2352x1568px; 45° FOV
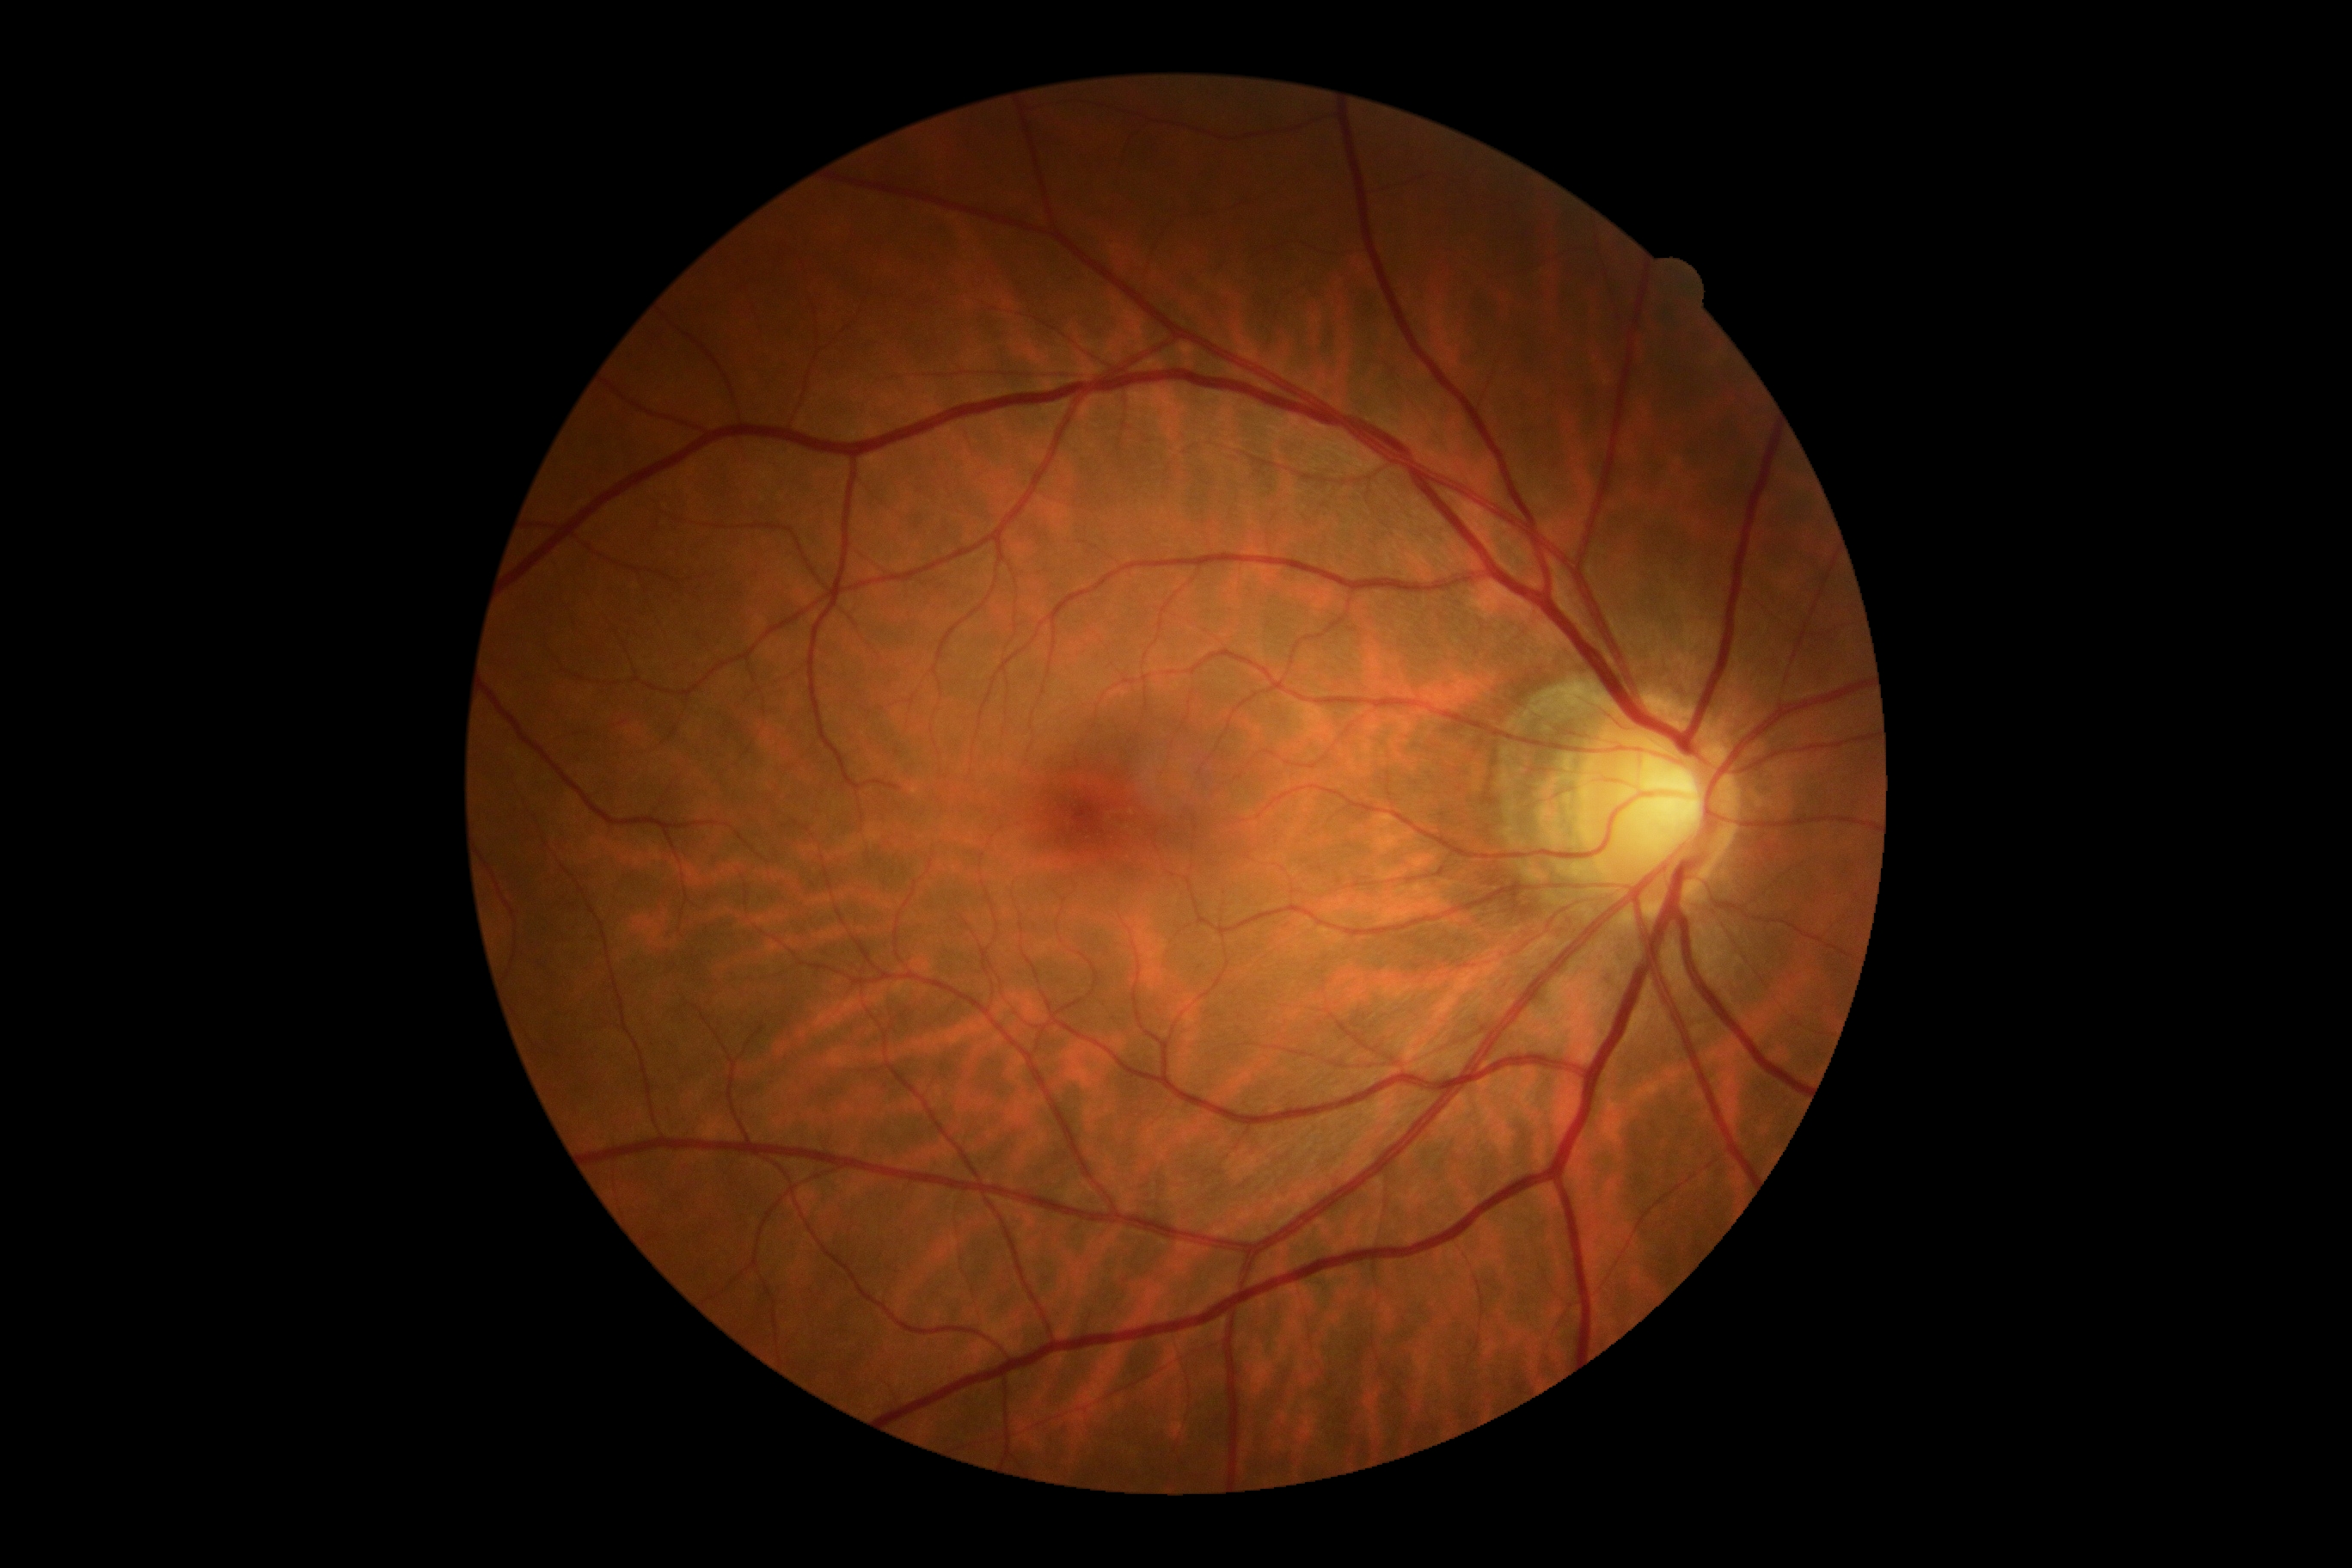
Diabetic retinopathy (DR): grade 0.